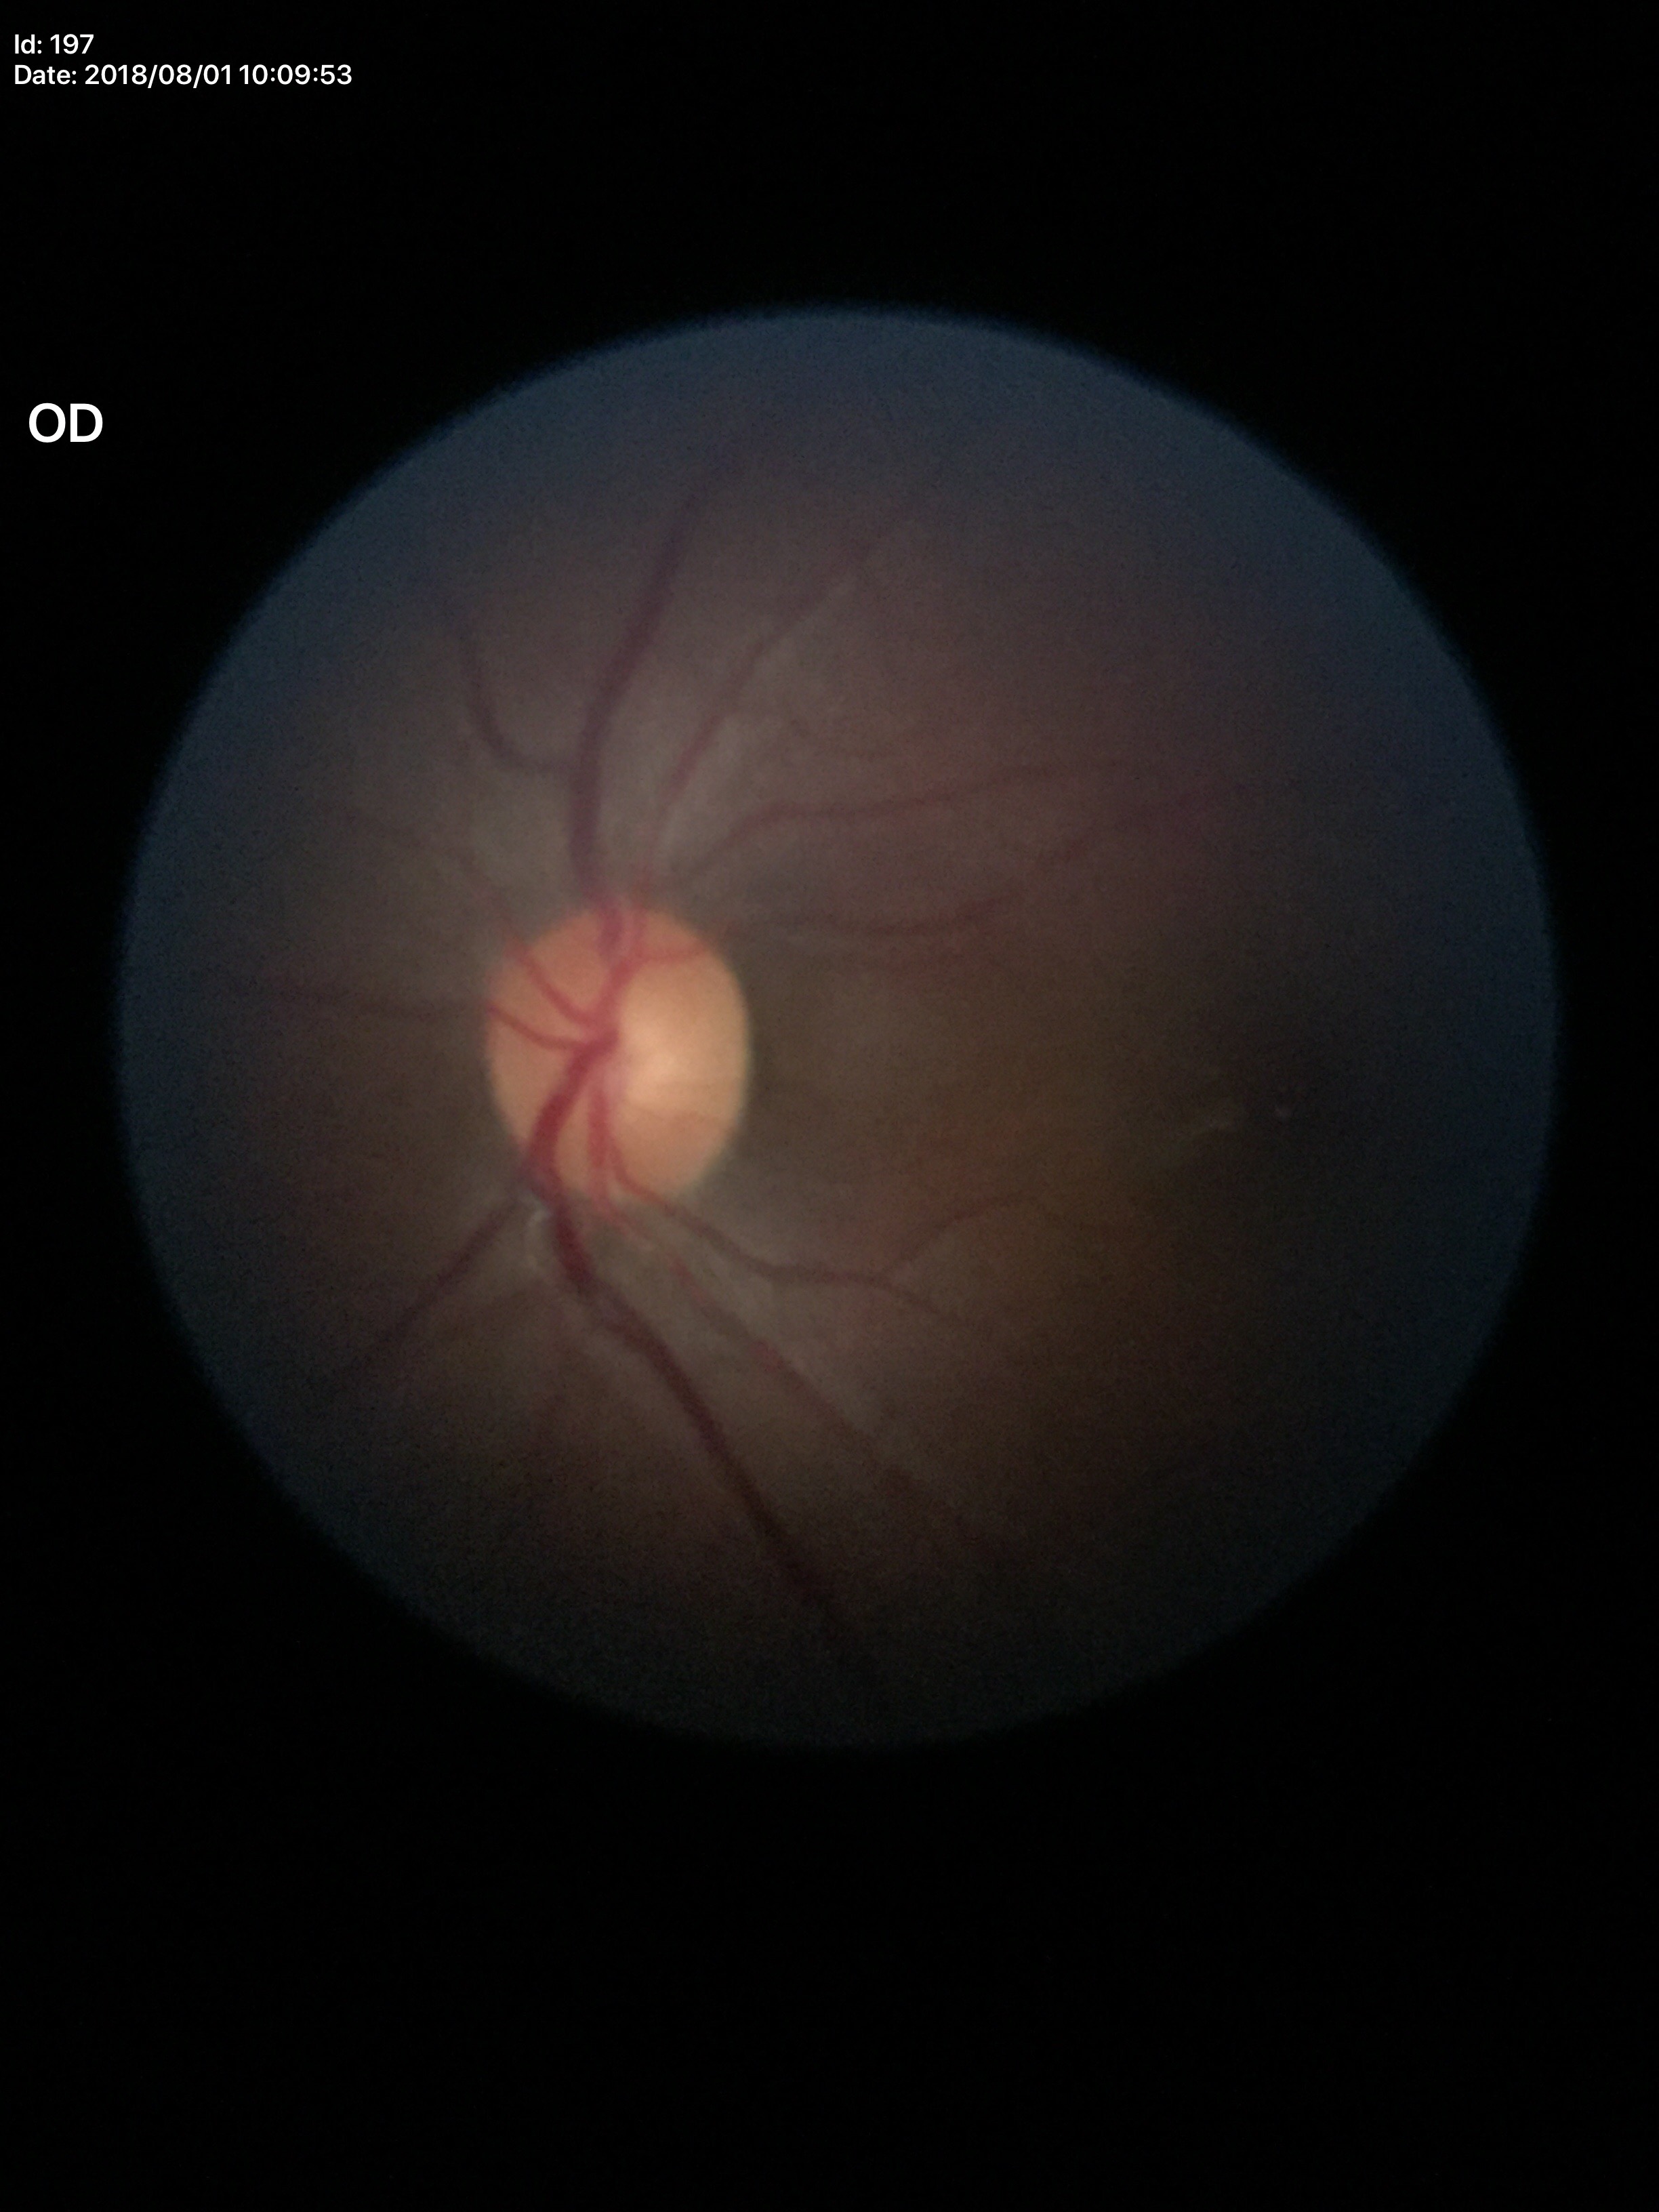
No glaucomatous findings (all 5 graders called normal). Vertical C/D ratio of 0.46. Horizontal cup-disc ratio of 0.43.